Tabletop color fundus camera image · 1924 by 1556 pixels
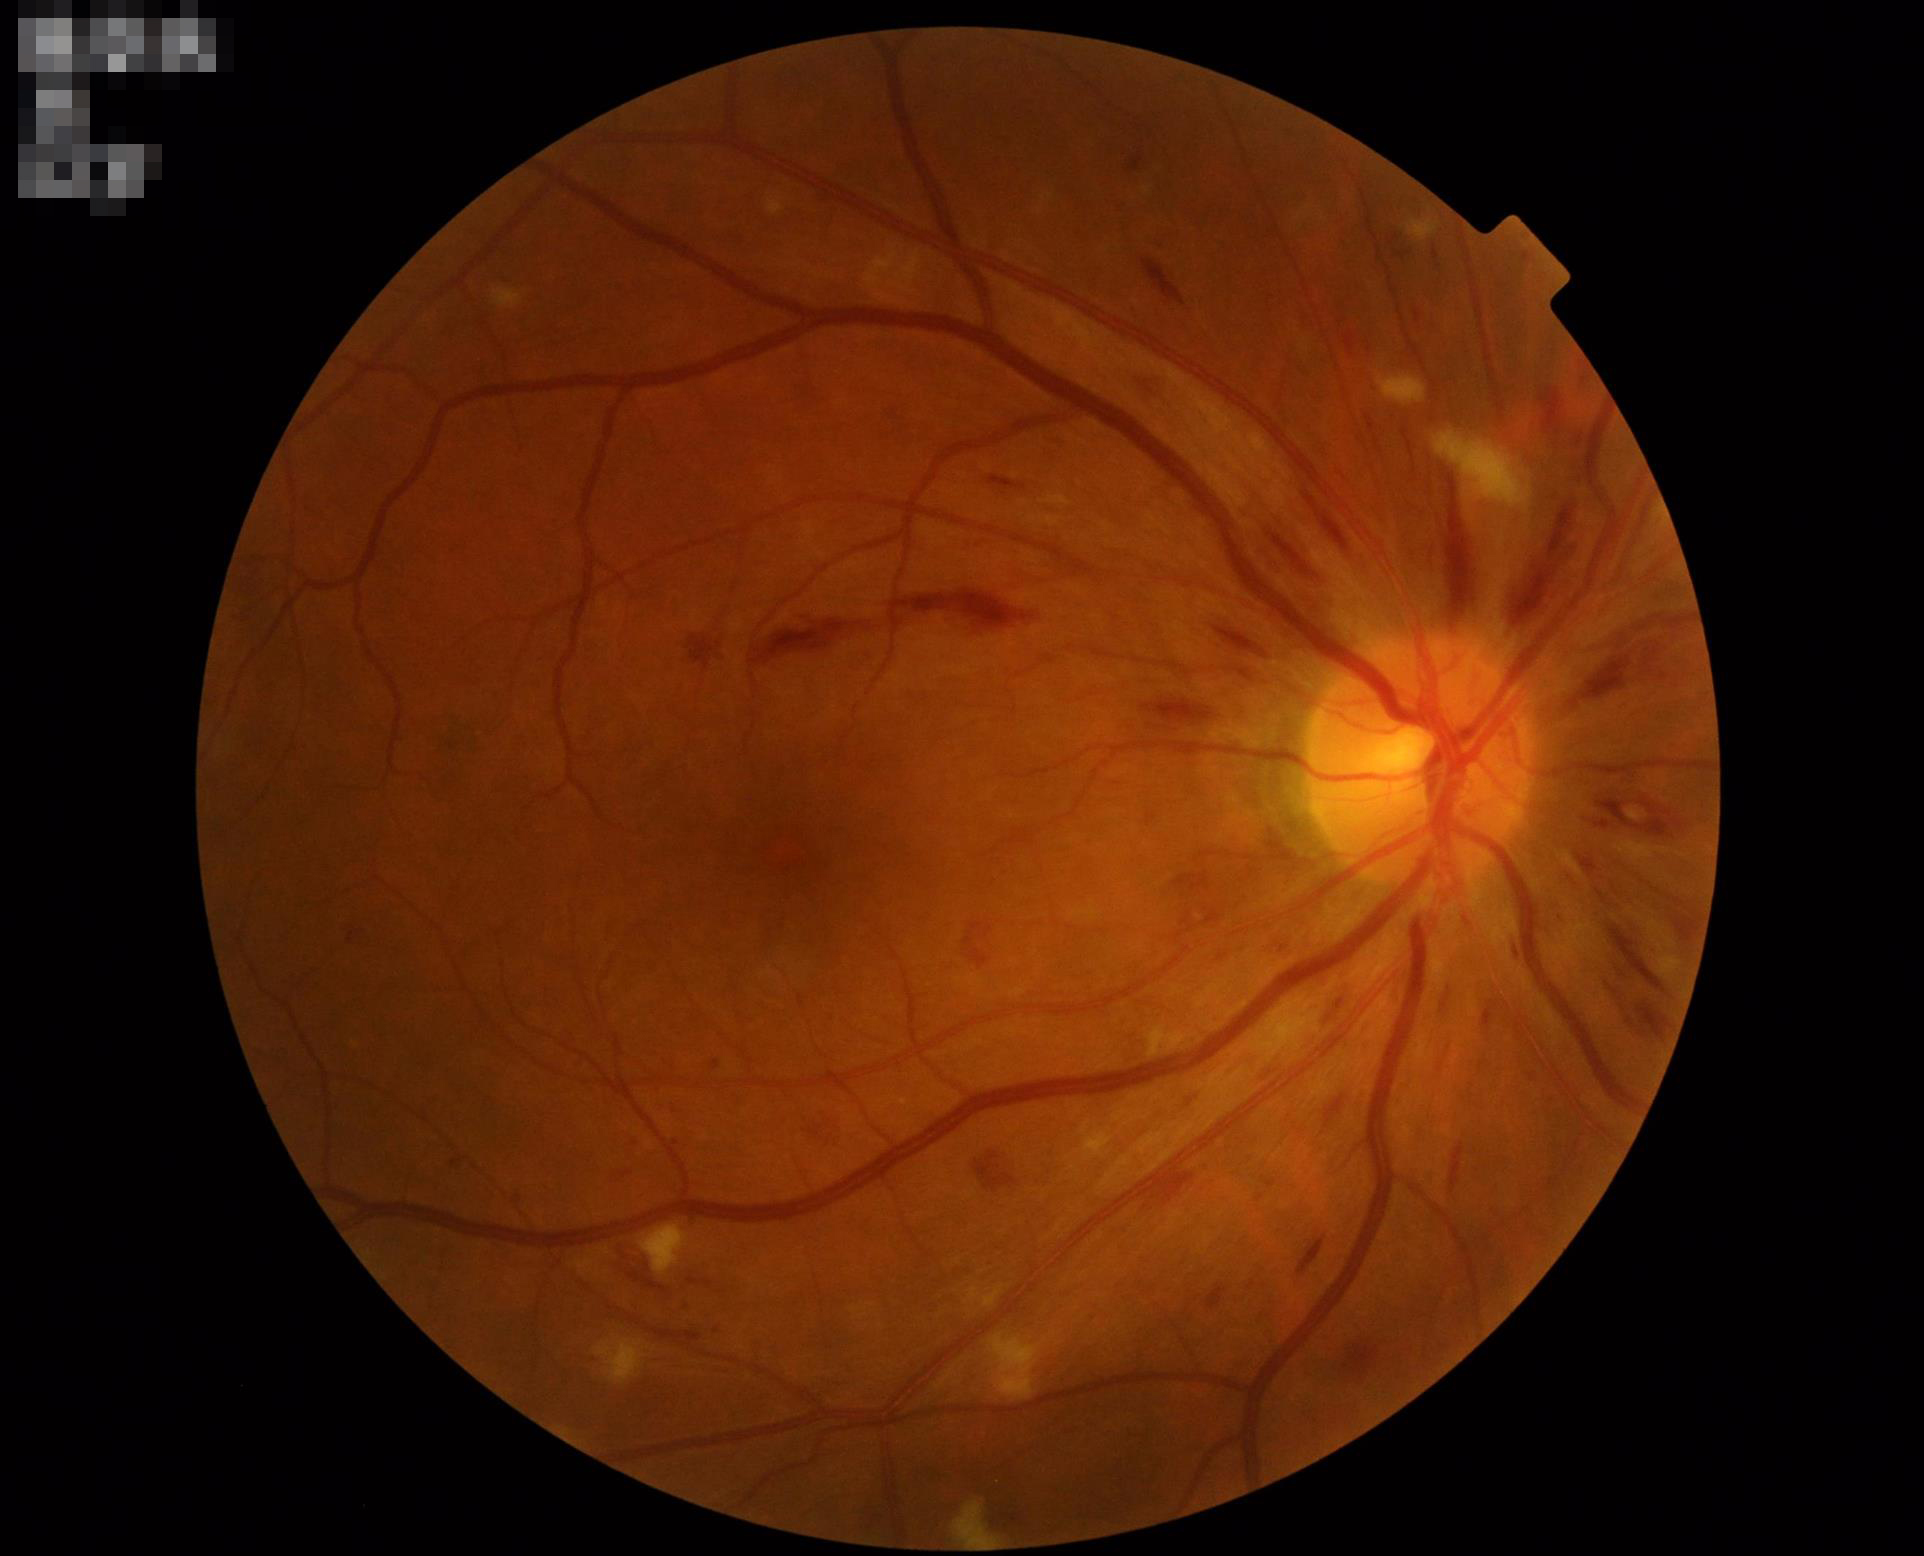

  clarity: optic disc, vessels, and background in focus
  contrast: wide intensity range, structures distinguishable
  illumination: good illumination and color balance
  overall_quality: good, gradable